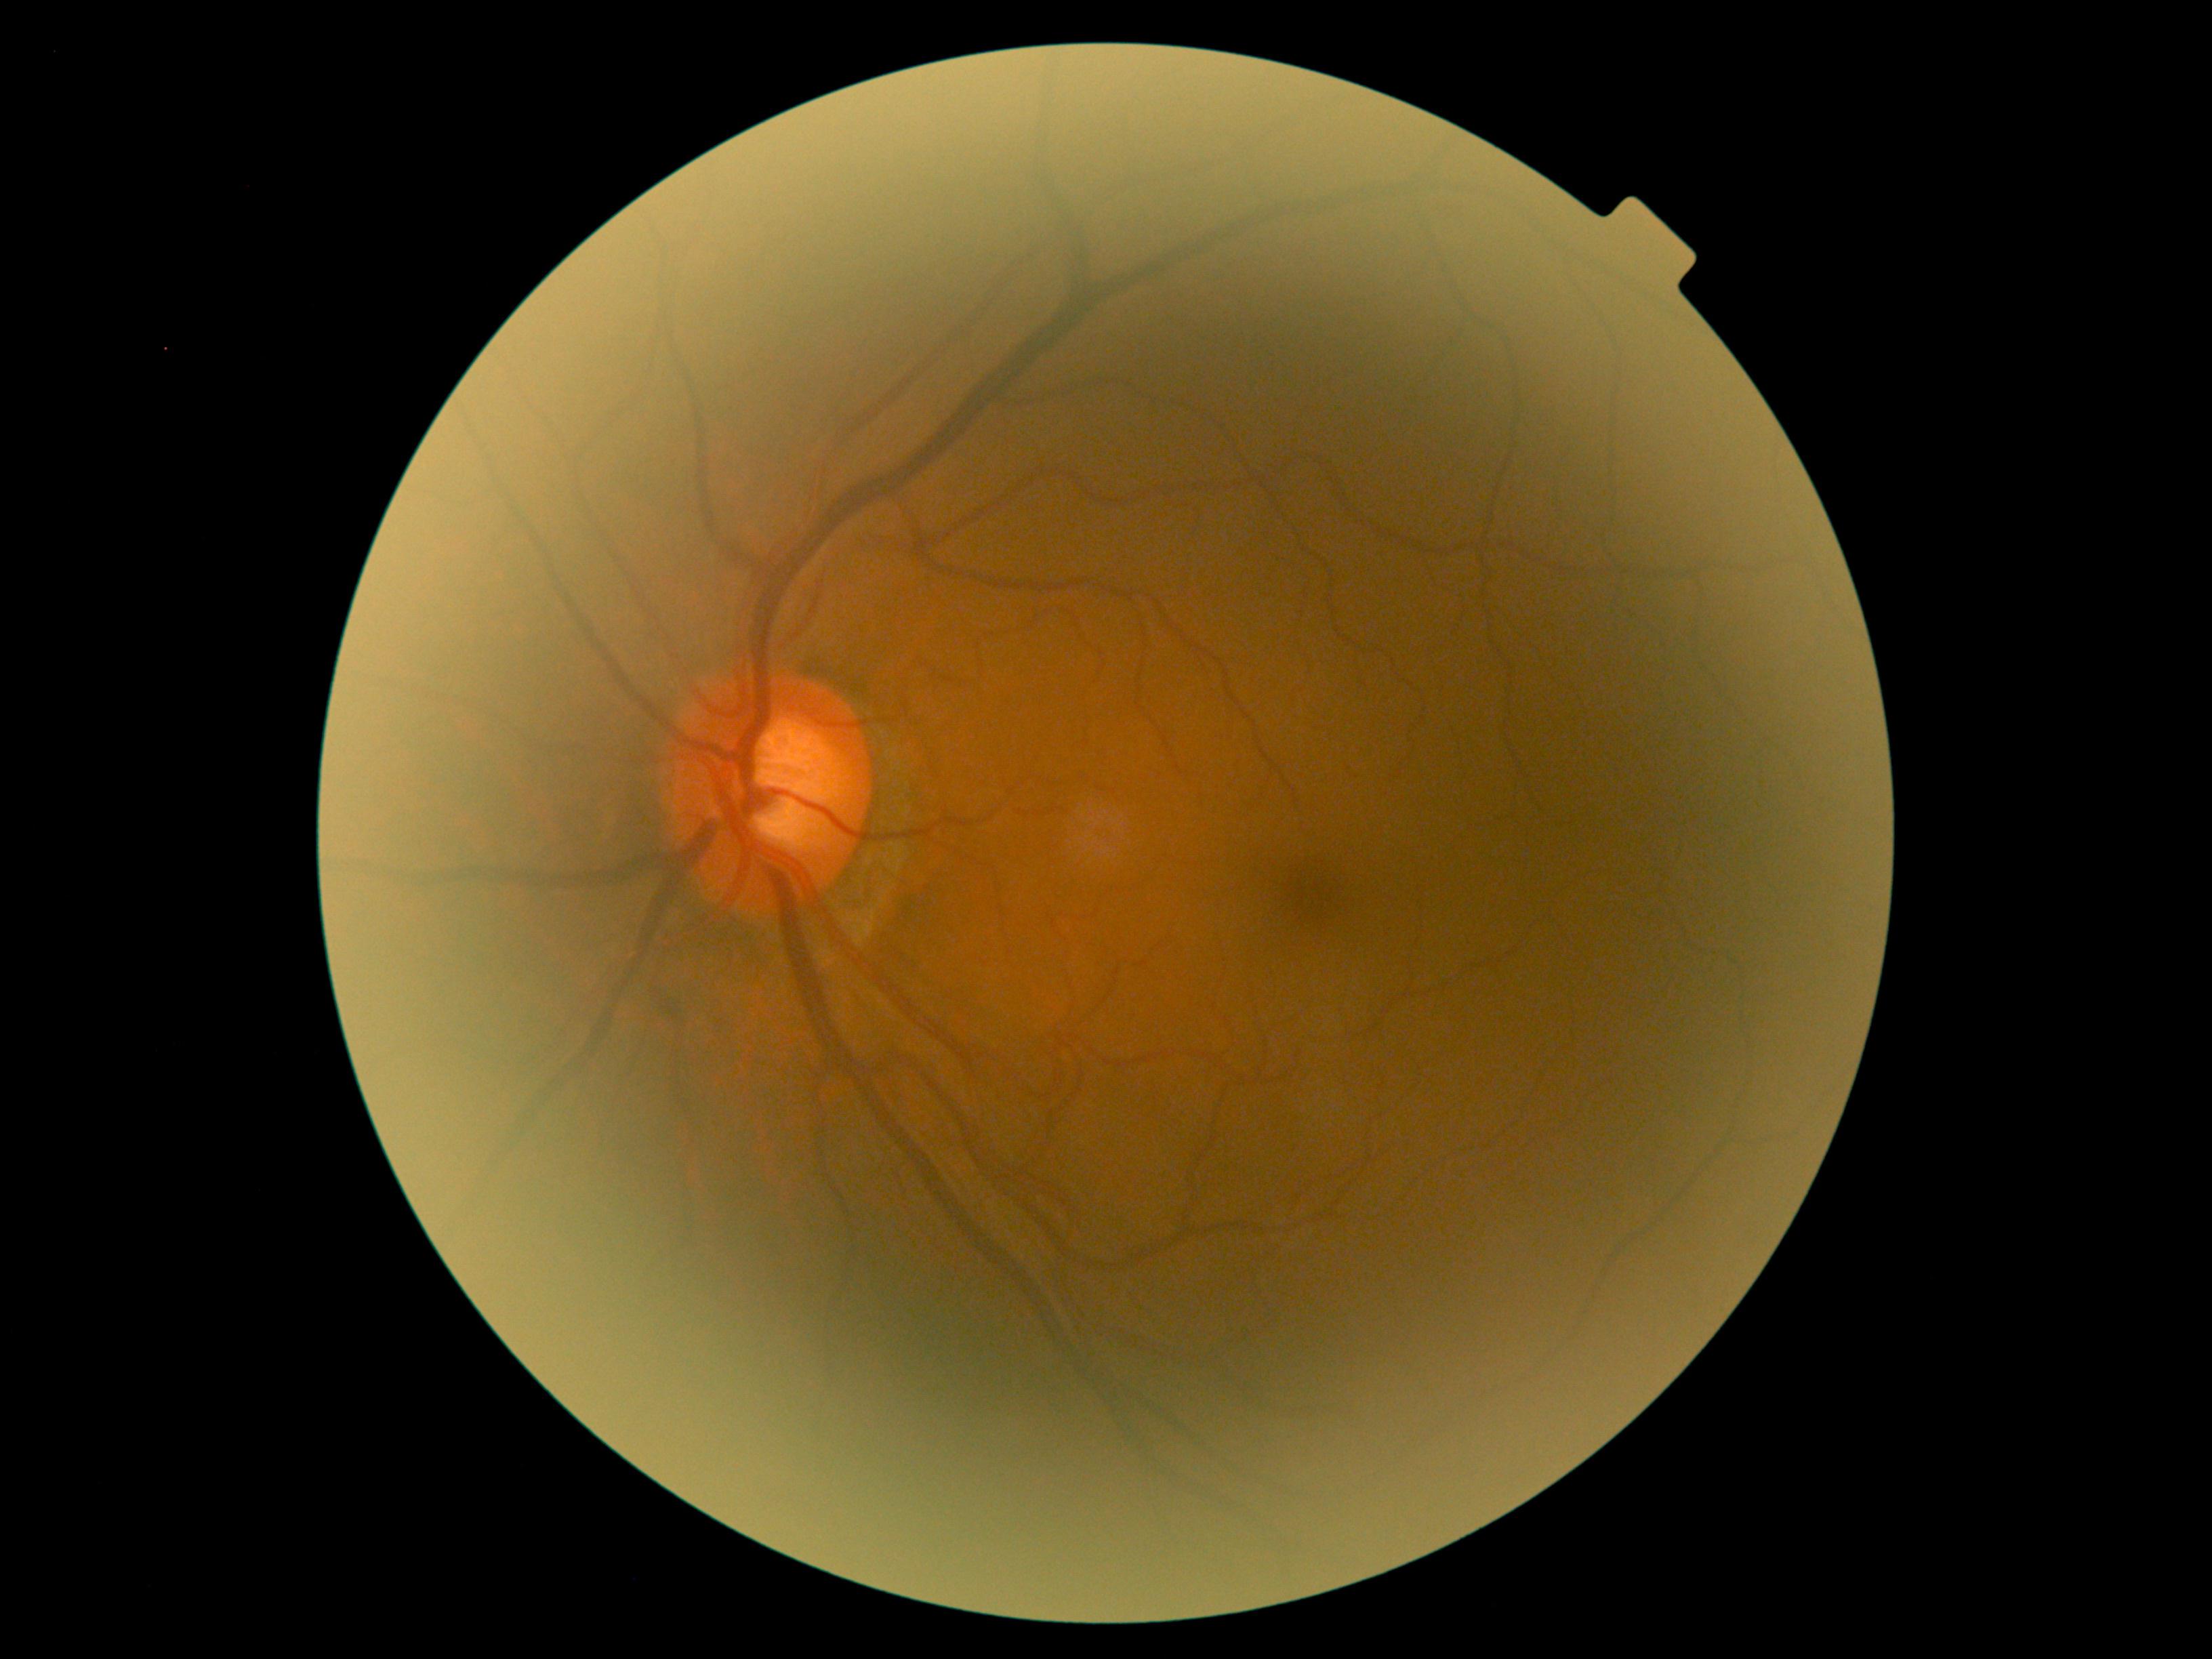
Annotations:
- retinopathy — 0